Wide-field fundus photograph from neonatal ROP screening:
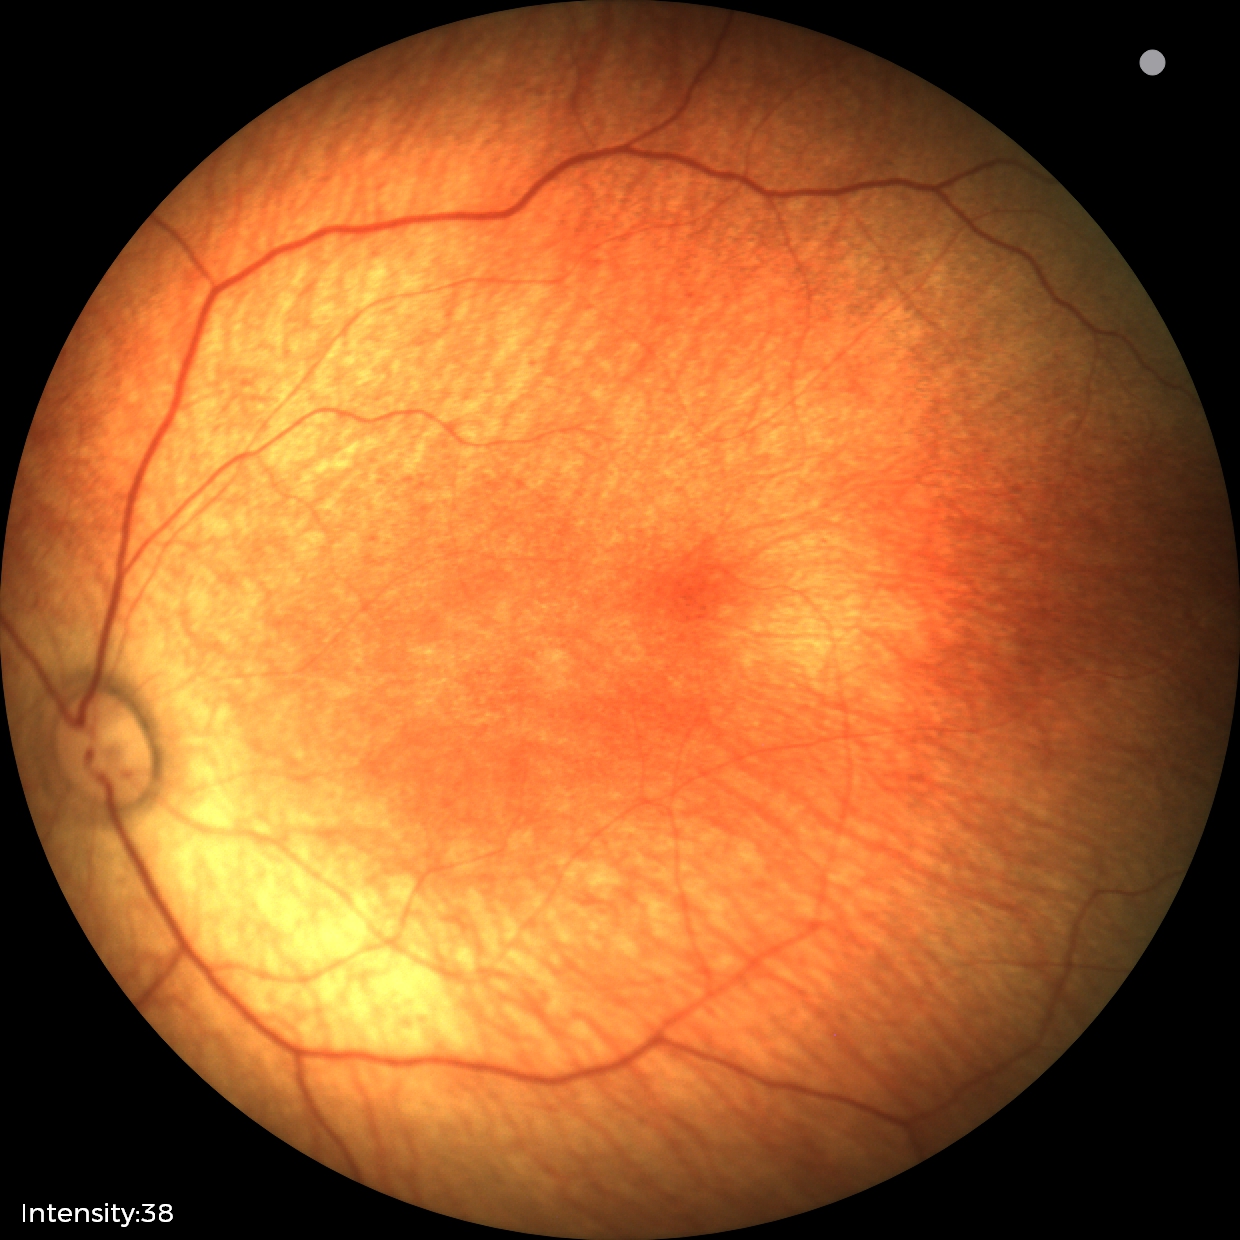 Physiological retinal appearance for postconceptual age.